2228x1652px, mydriatic (tropicamide and phenylephrine).
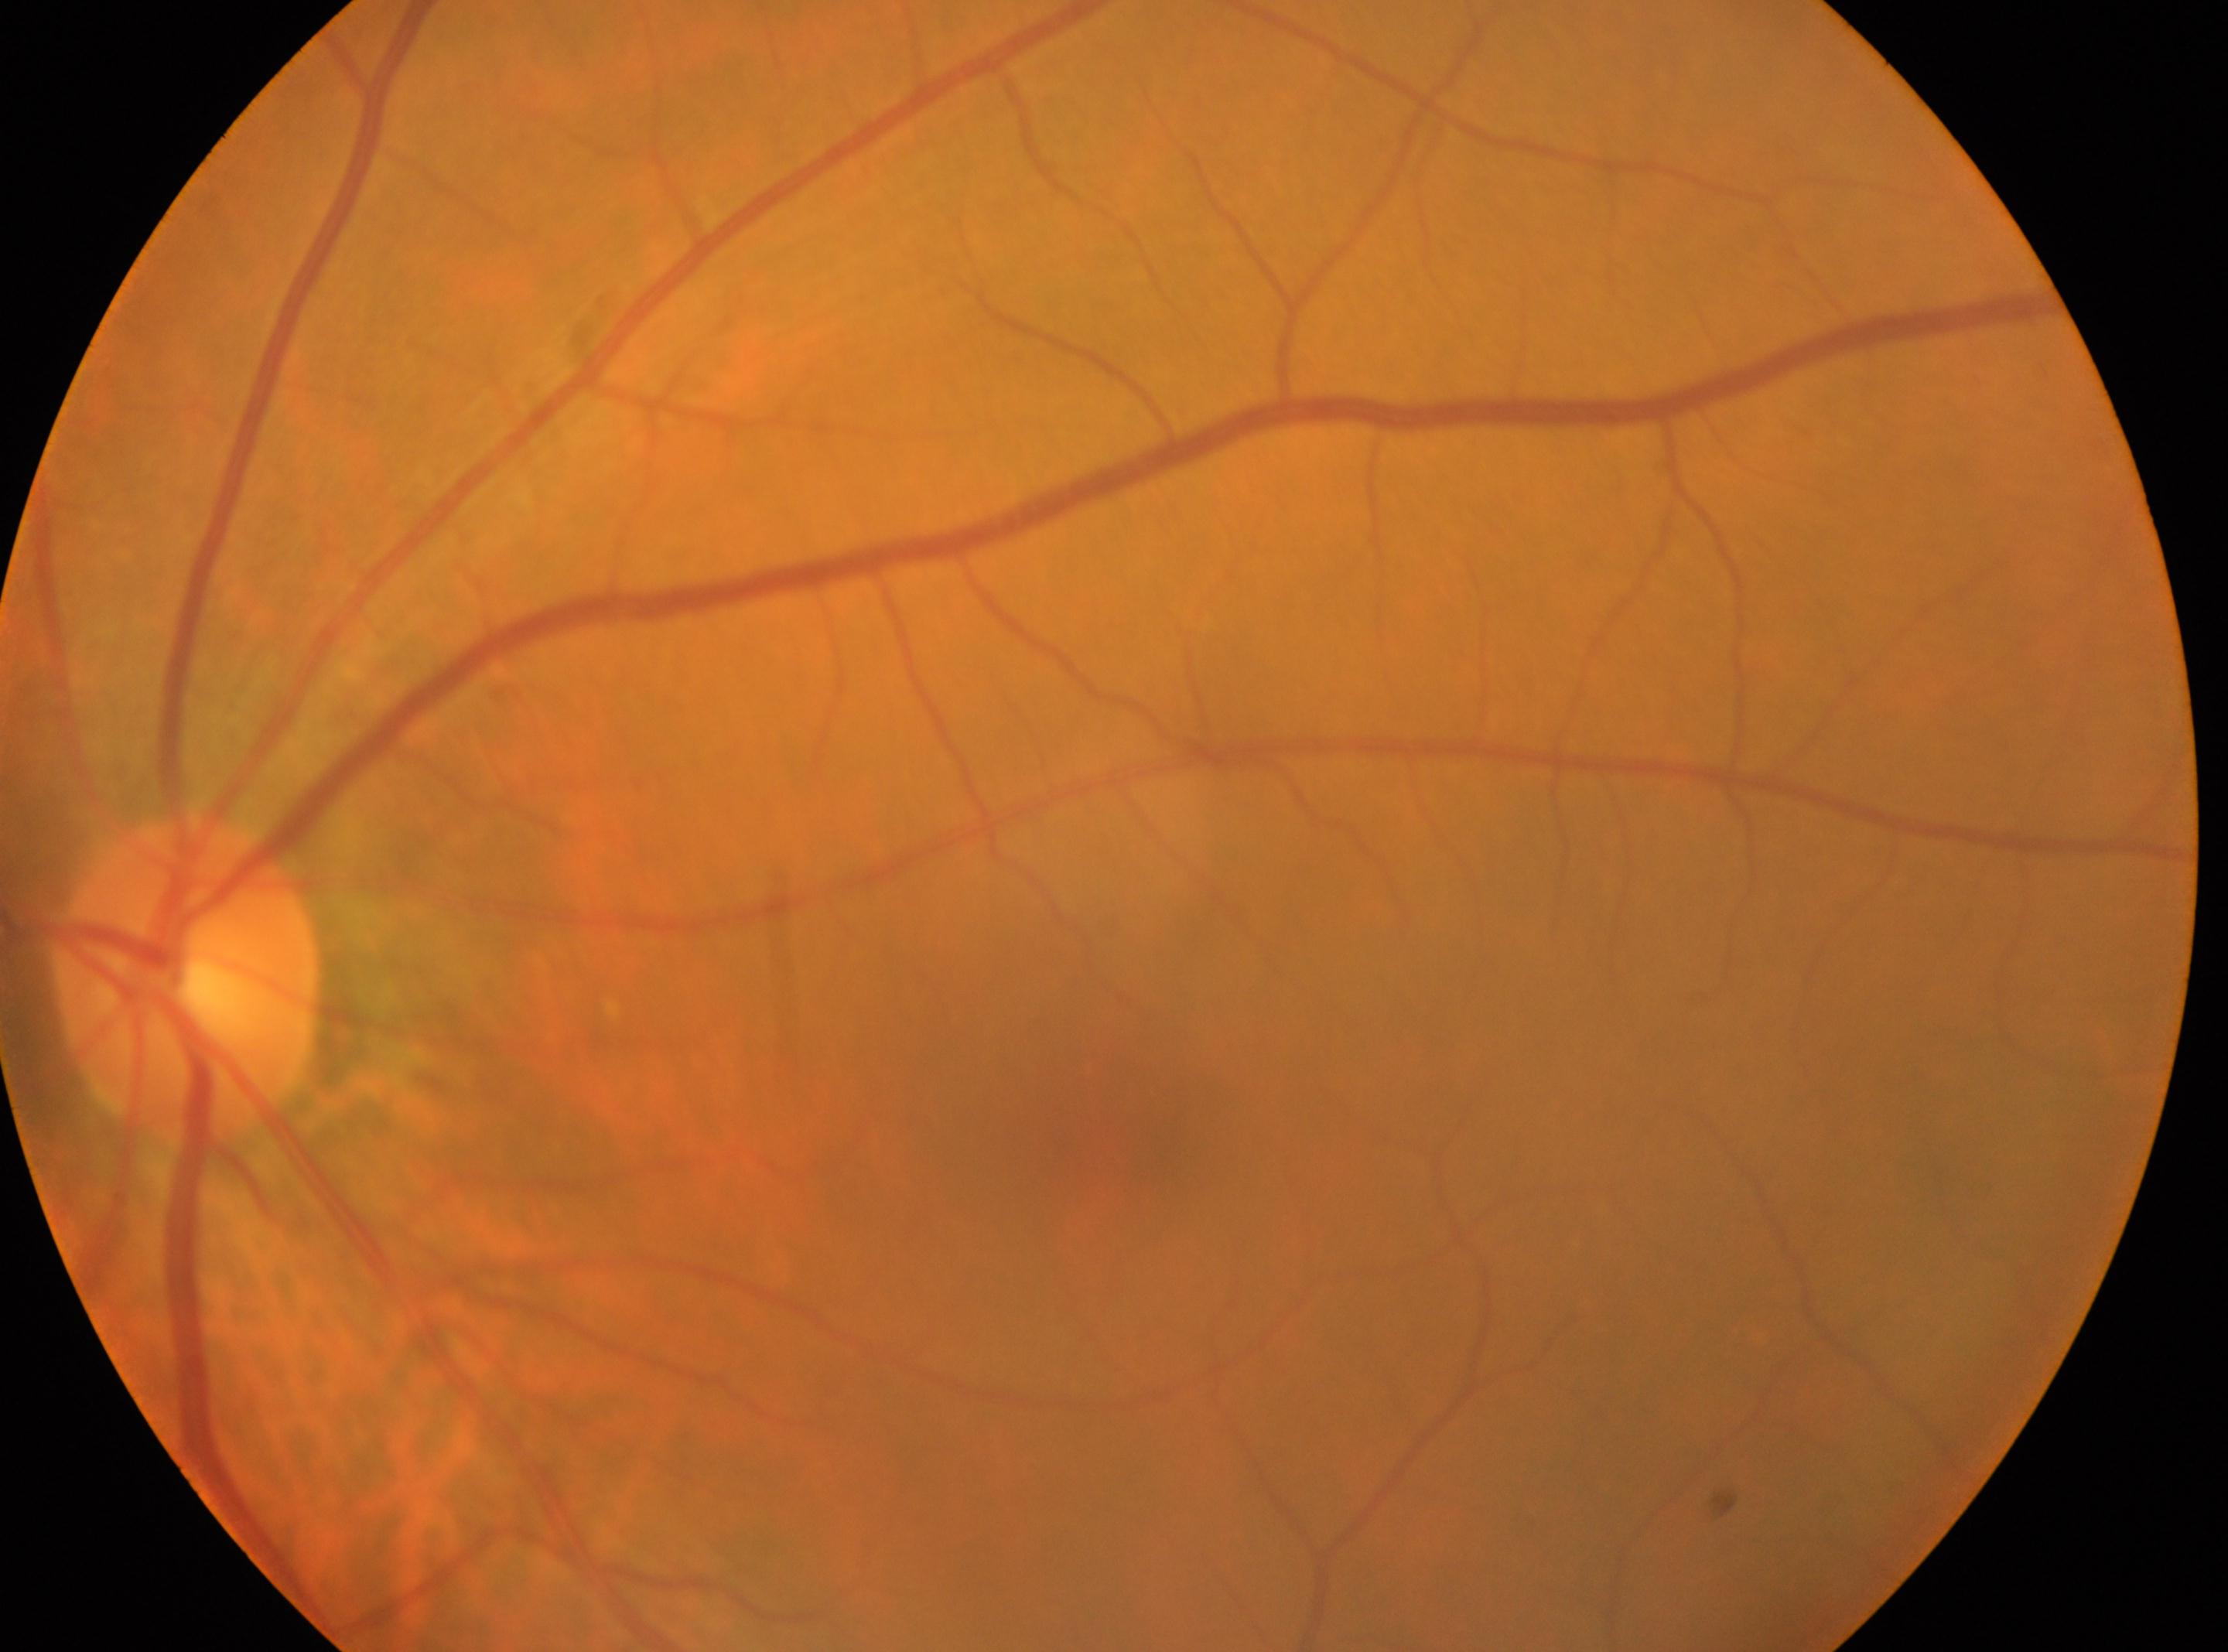
DR severity = grade 0 | macula center = [1092, 1135] | laterality = the left eye | ONH = [188, 981].